Acquired with a NIDEK AFC-230 · color fundus photograph.
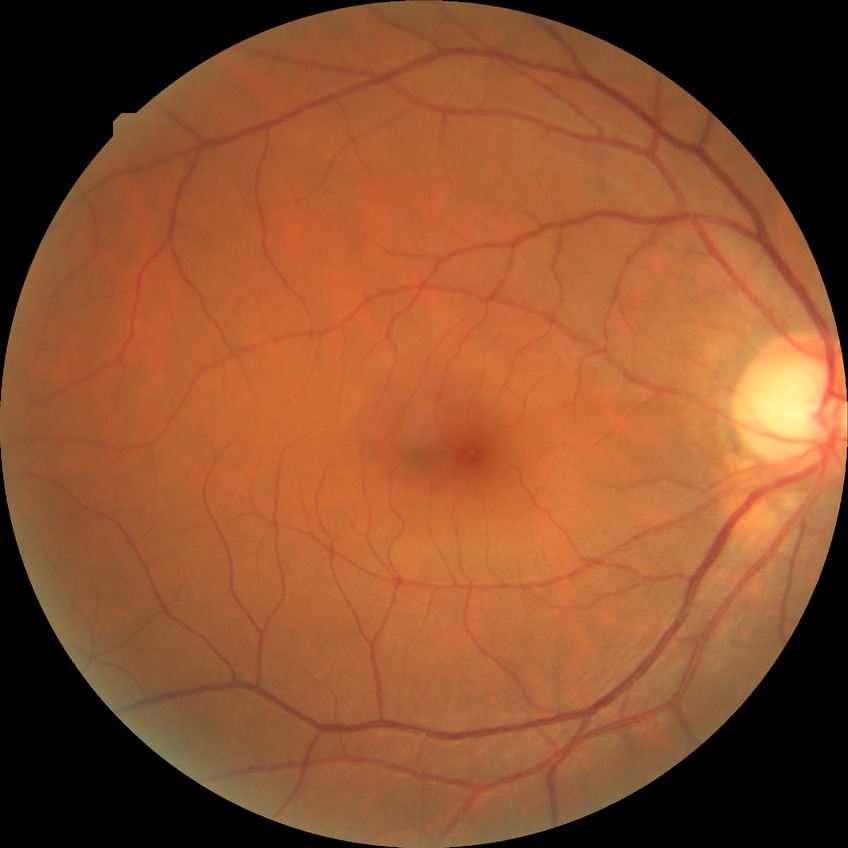

Diabetic retinopathy (DR): no diabetic retinopathy (NDR).